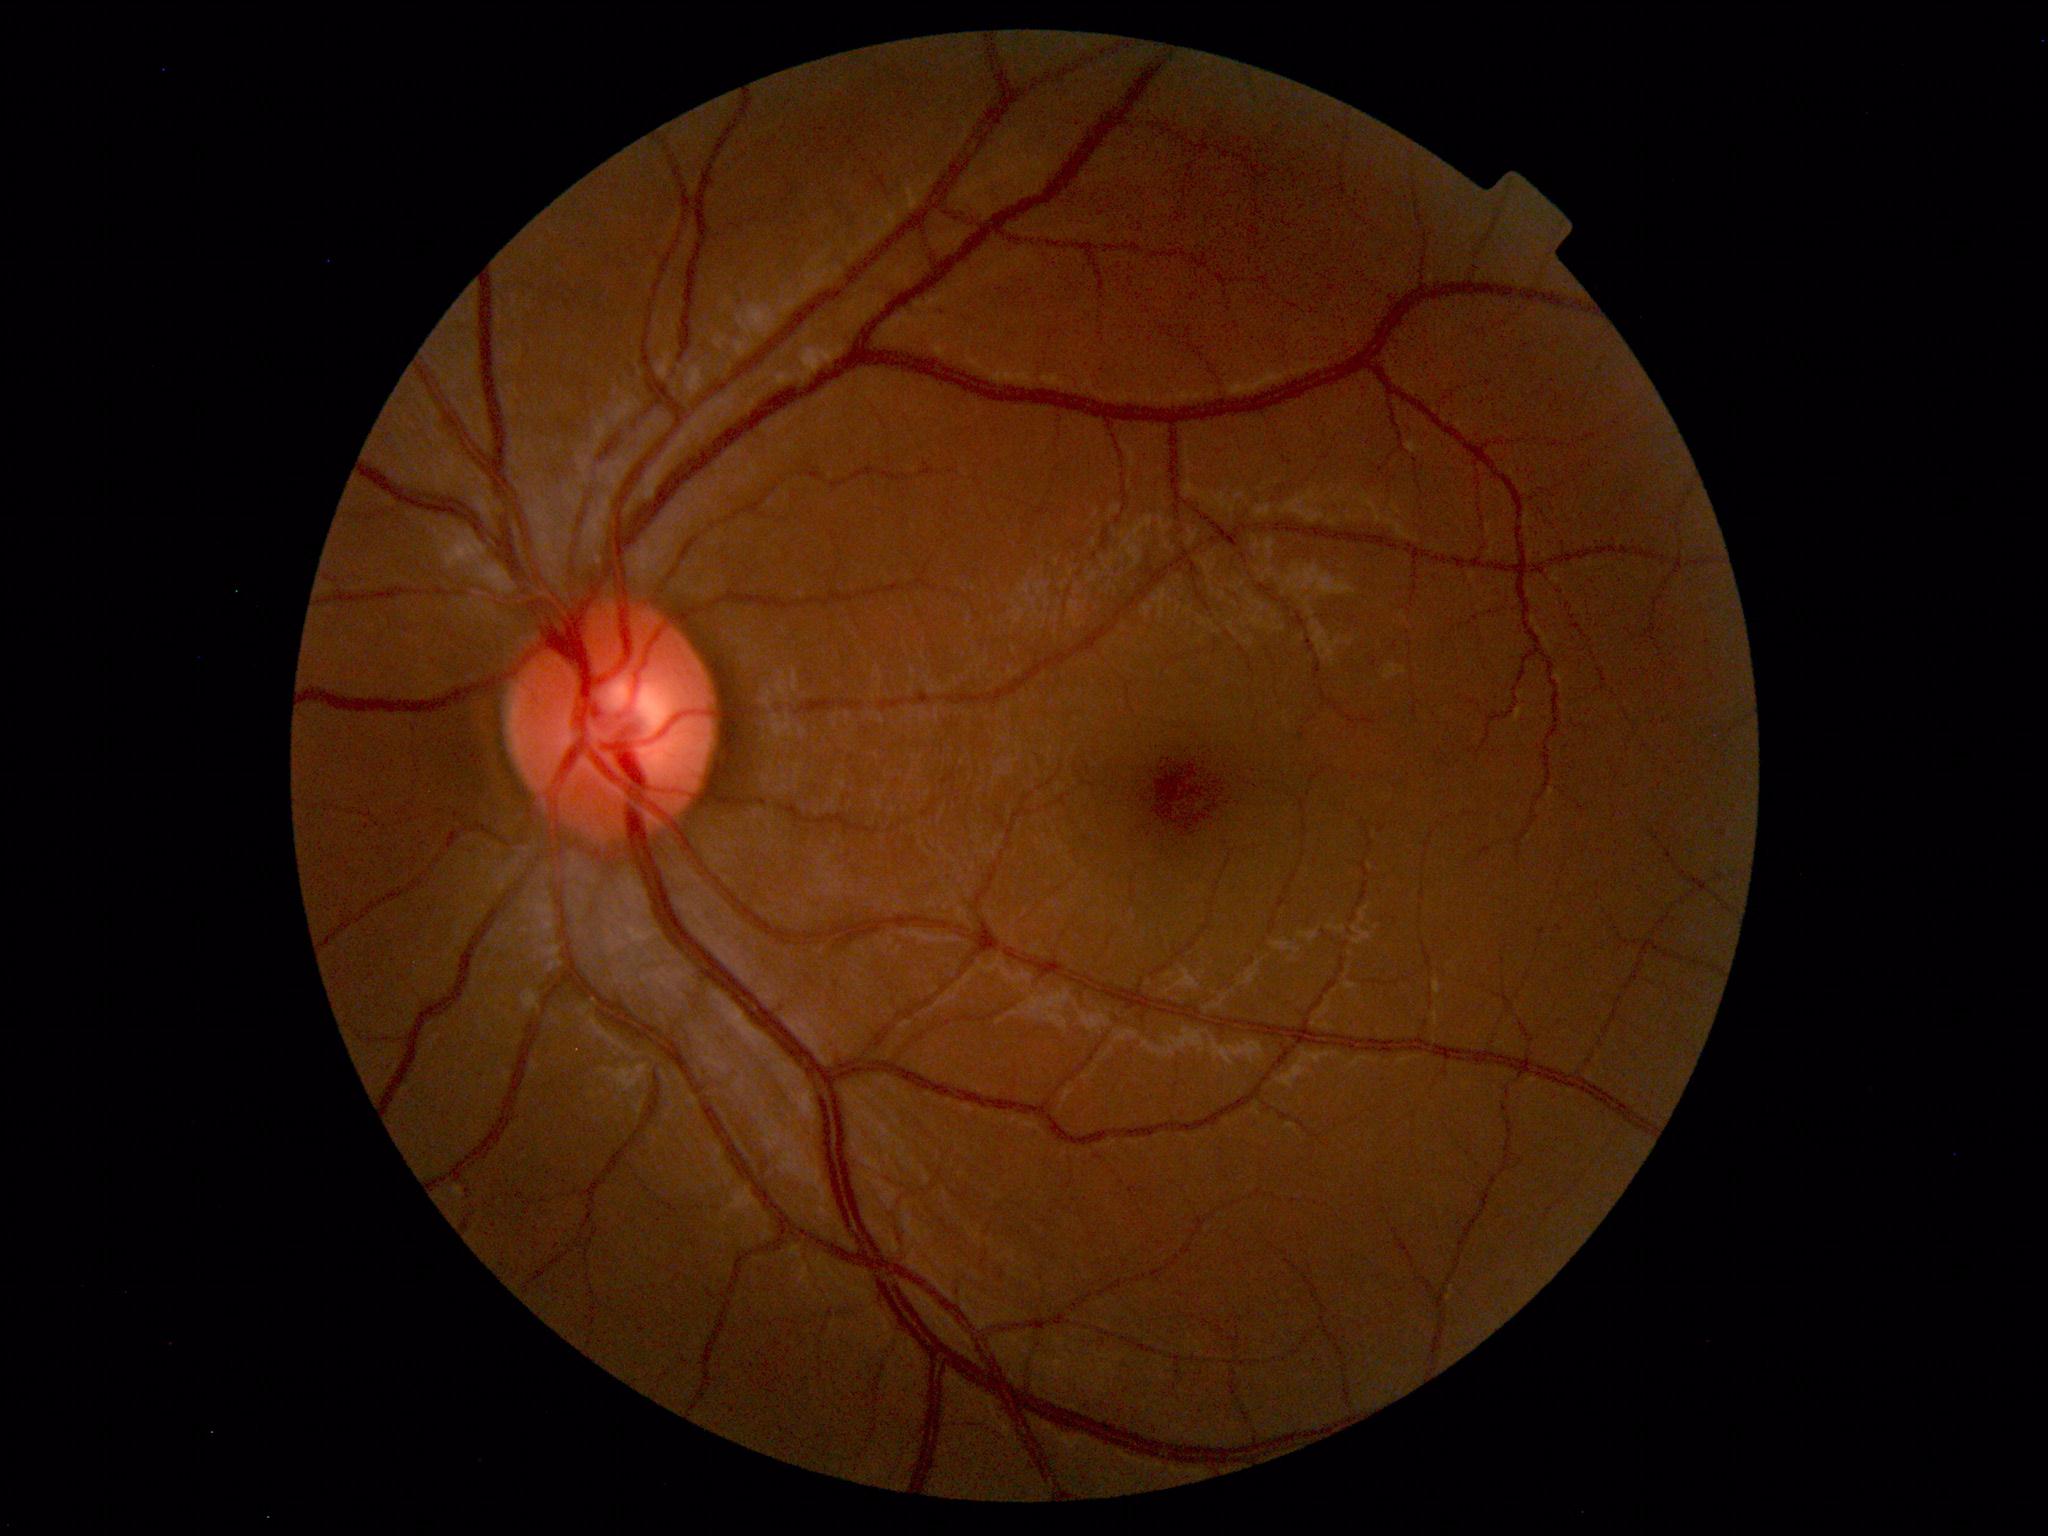 Findings: no abnormalities.